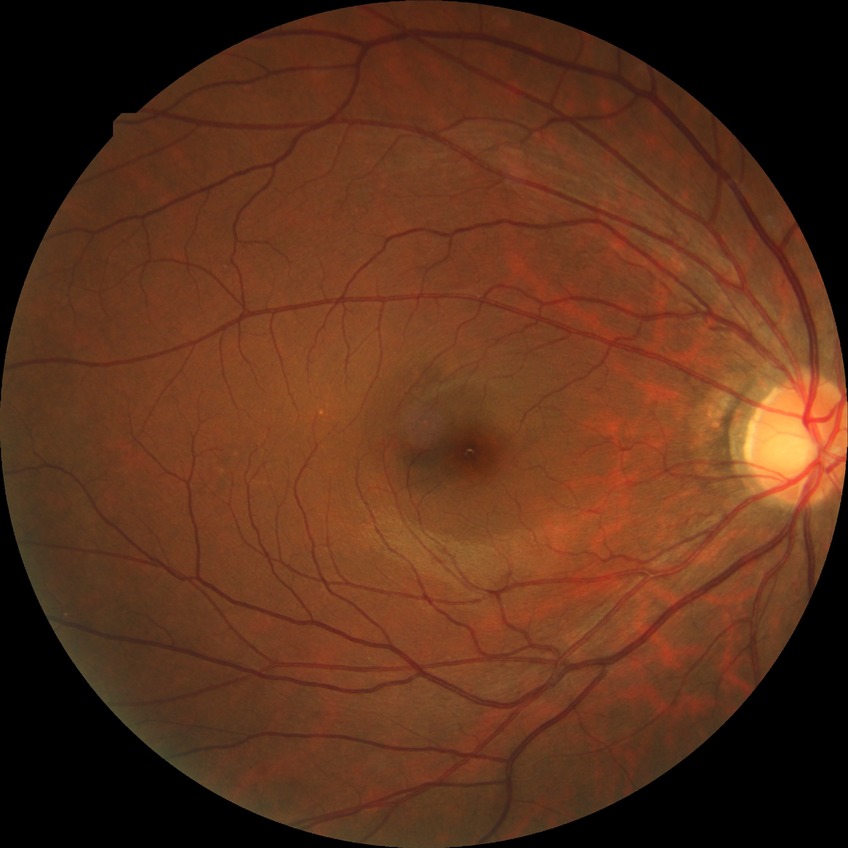

Assessment:
- Davis grade: NDR